45° FOV.
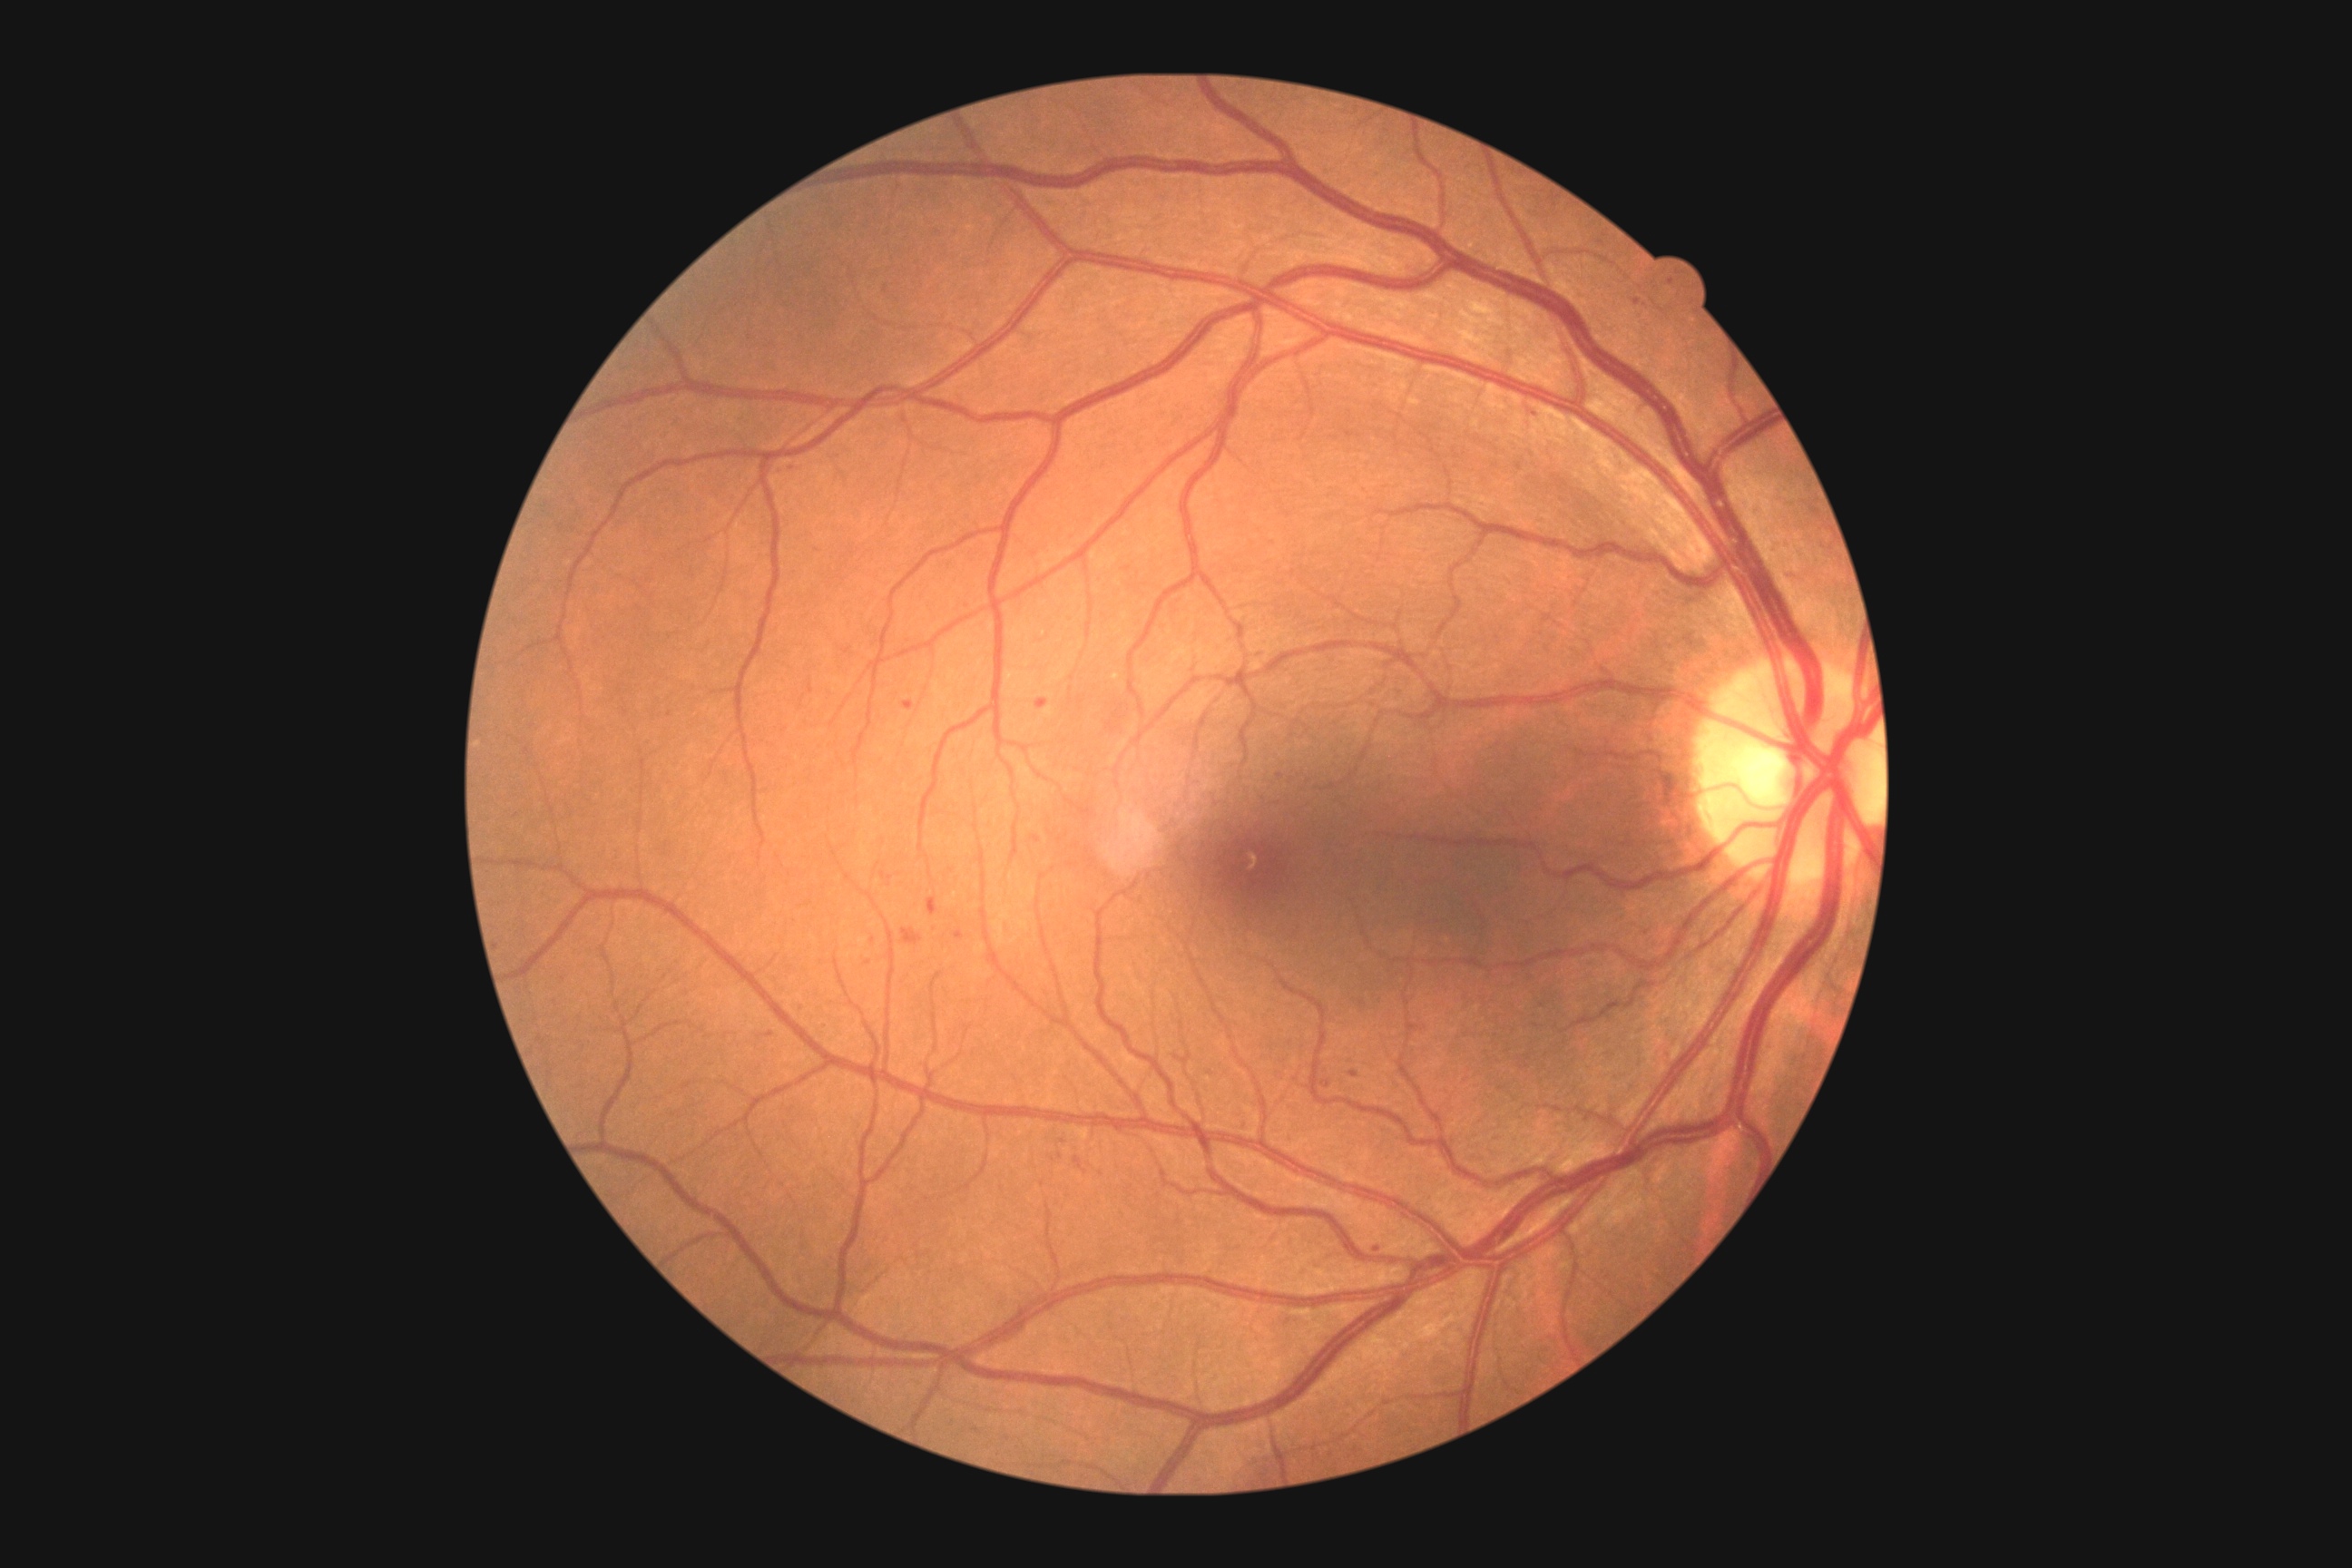 Diabetic retinopathy grade: moderate NPDR (2).